Image size 2352x1568: 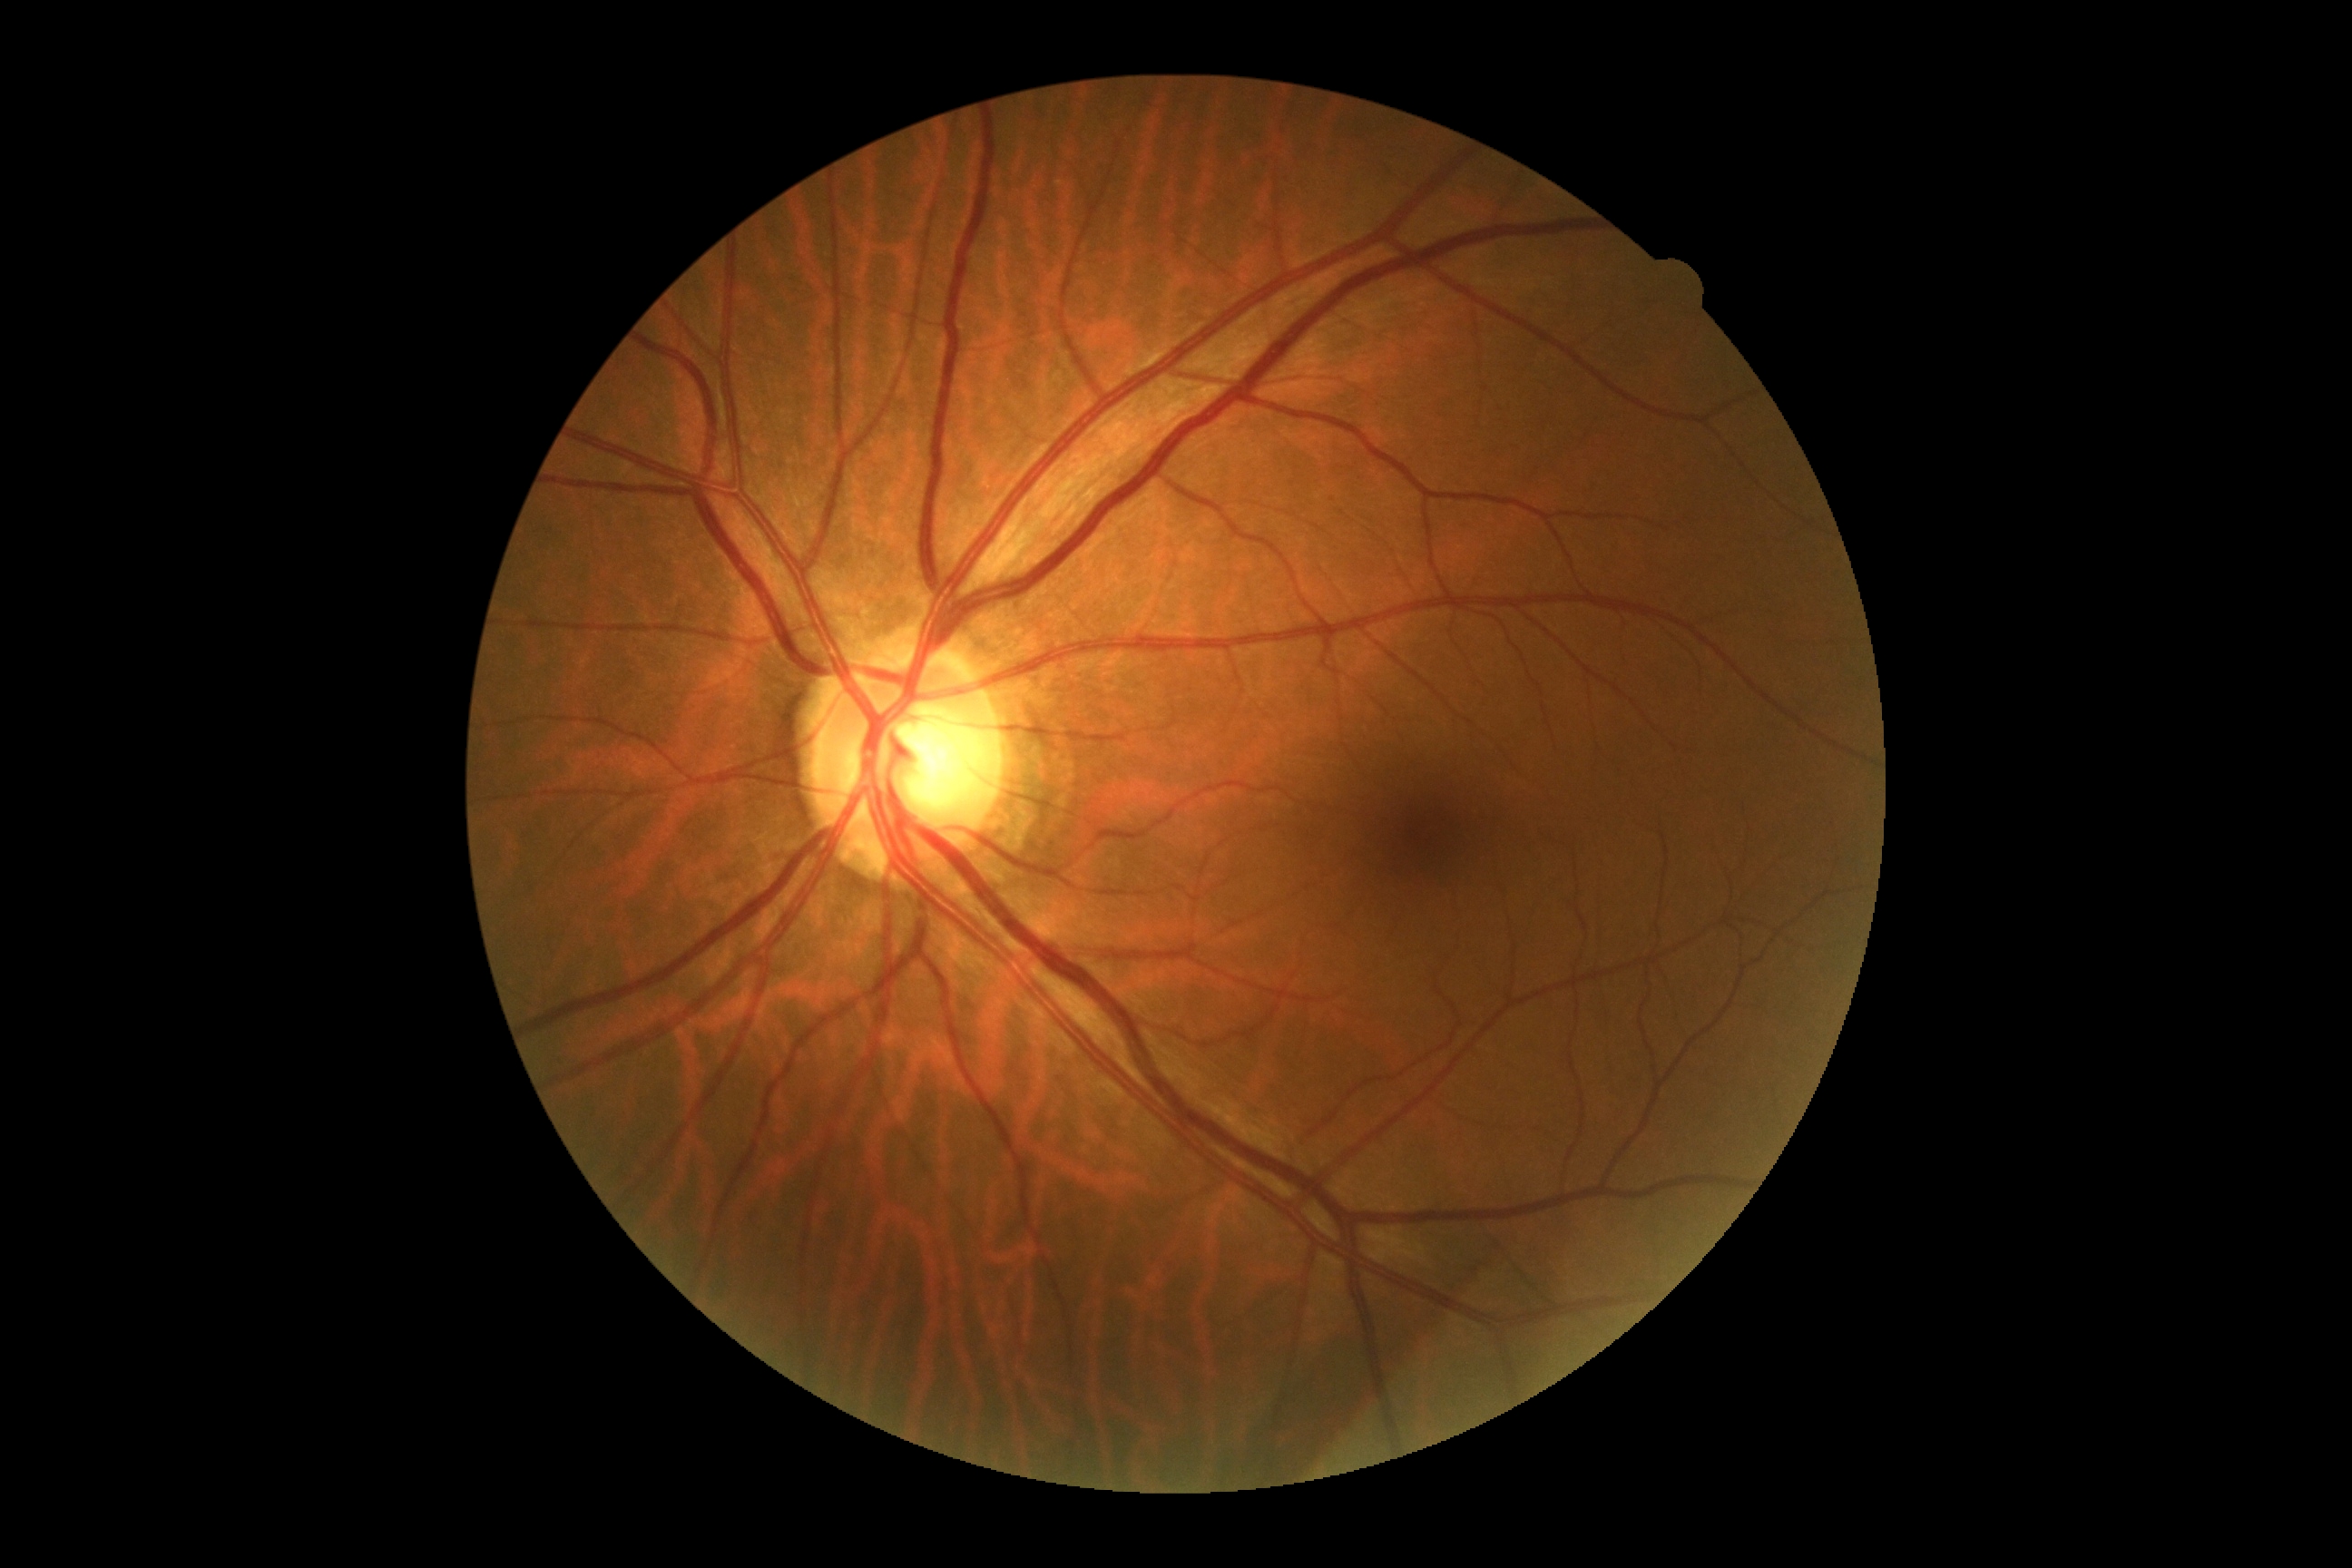

No DR findings. DR stage: 0/4.